848 by 848 pixels: 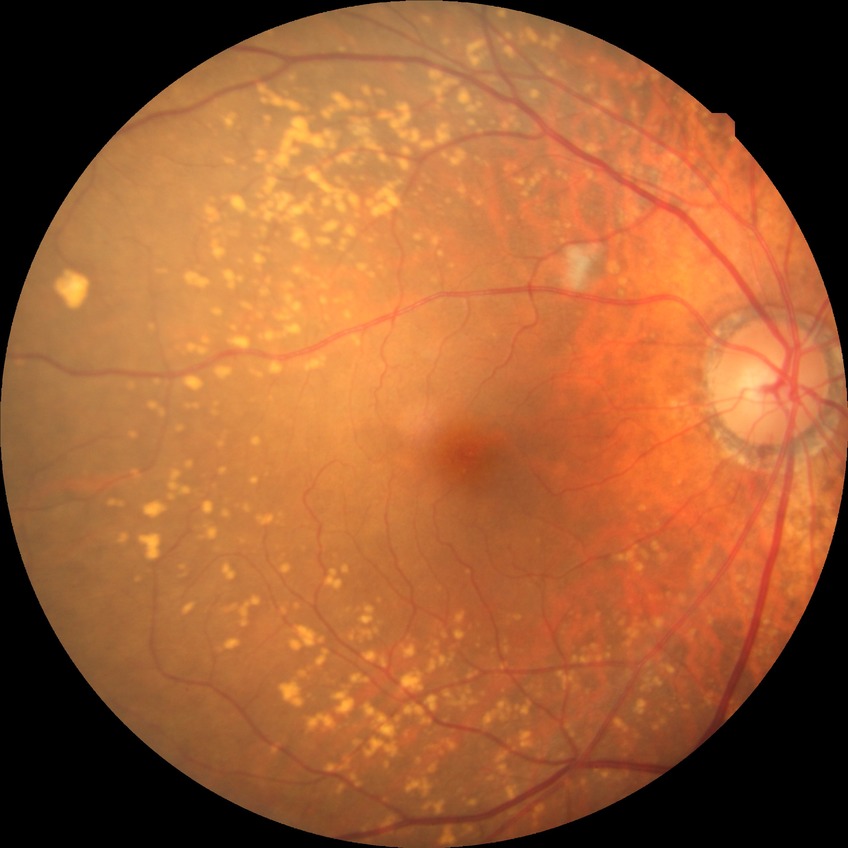 diabetic retinopathy severity=no diabetic retinopathy.